Davis DR grading
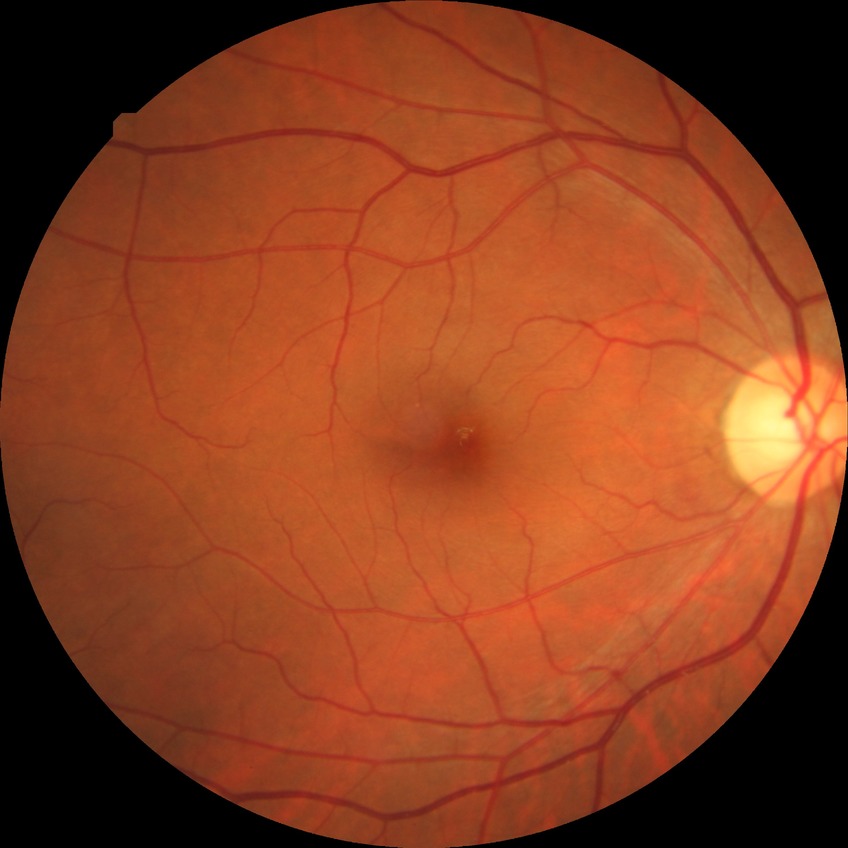
* diabetic retinopathy (DR) — no diabetic retinopathy (NDR)